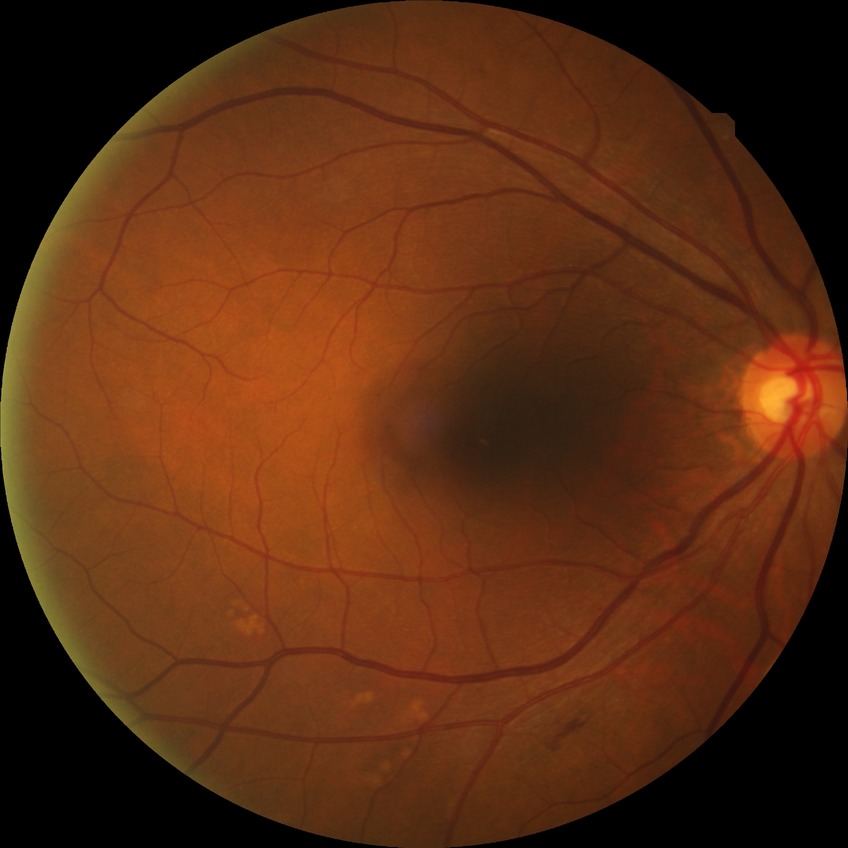 * retinopathy stage — no diabetic retinopathy